1240 by 1240 pixels. Phoenix ICON wide-field infant fundus image.
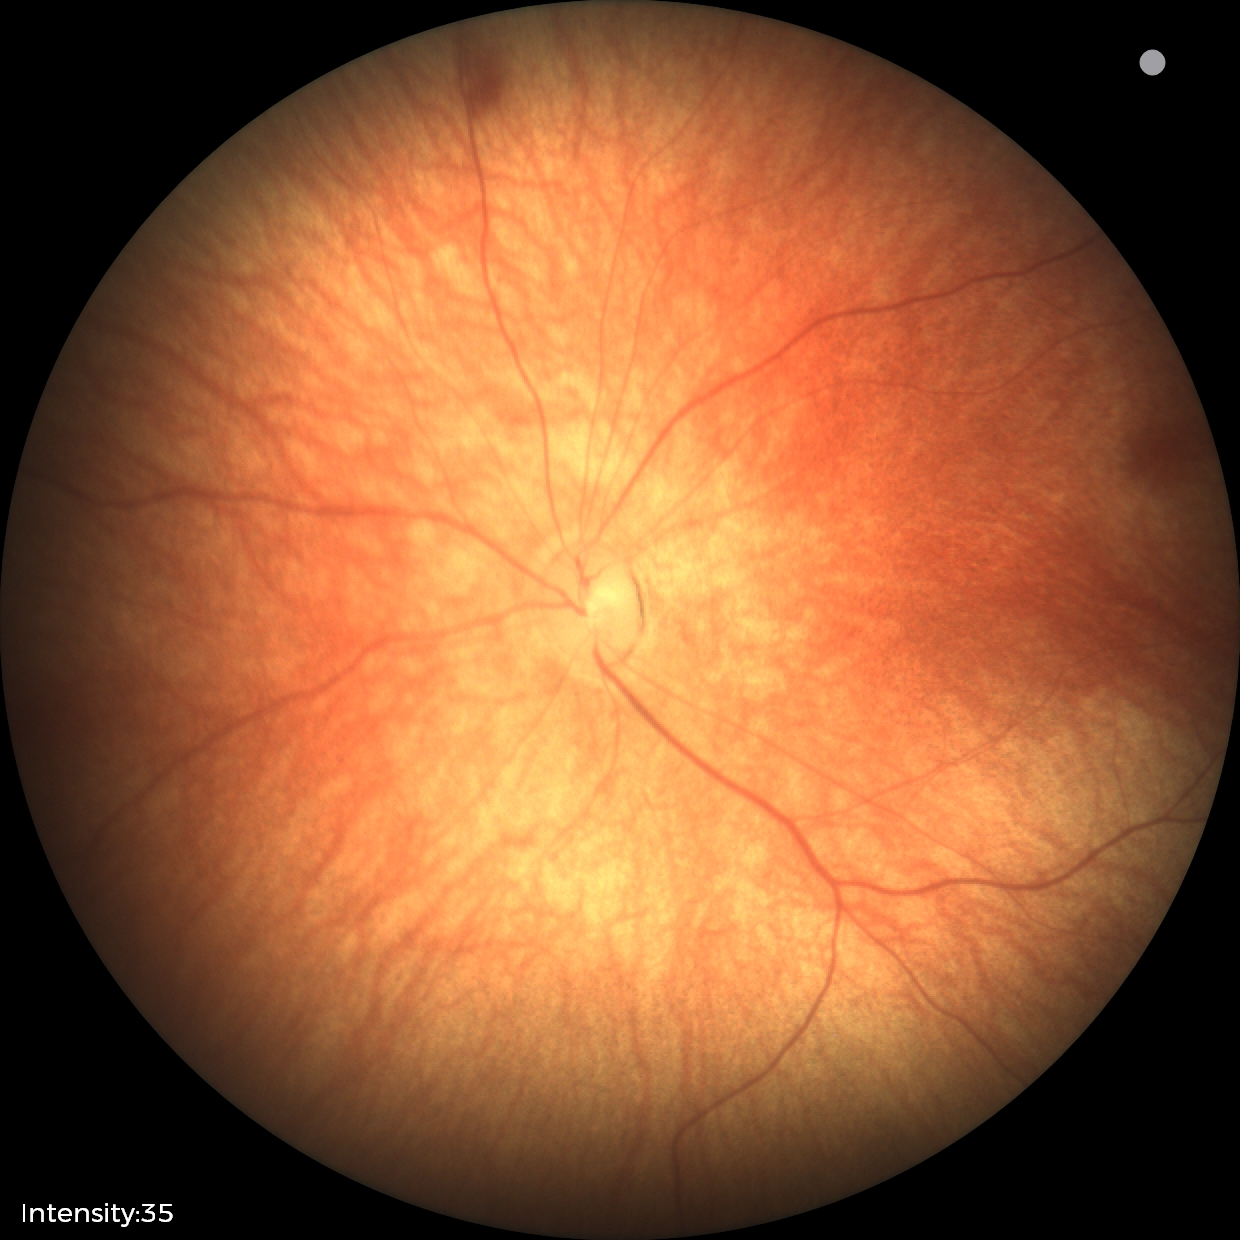

Q: What is the screening diagnosis?
A: retinal hemorrhages